Infant wide-field retinal image · image size 640x480: 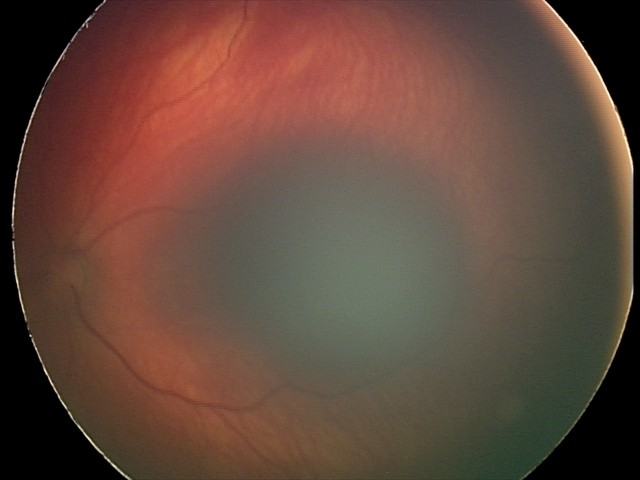

Assessment: retinal hemorrhages.